Fundus photograph cropped around the optic nerve head
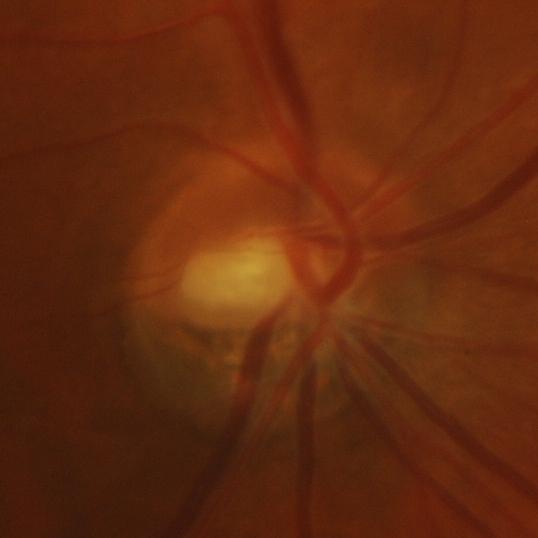
Diagnosis = glaucomatous findings.